Image size 871x871, ONH-centered crop from a color fundus image — 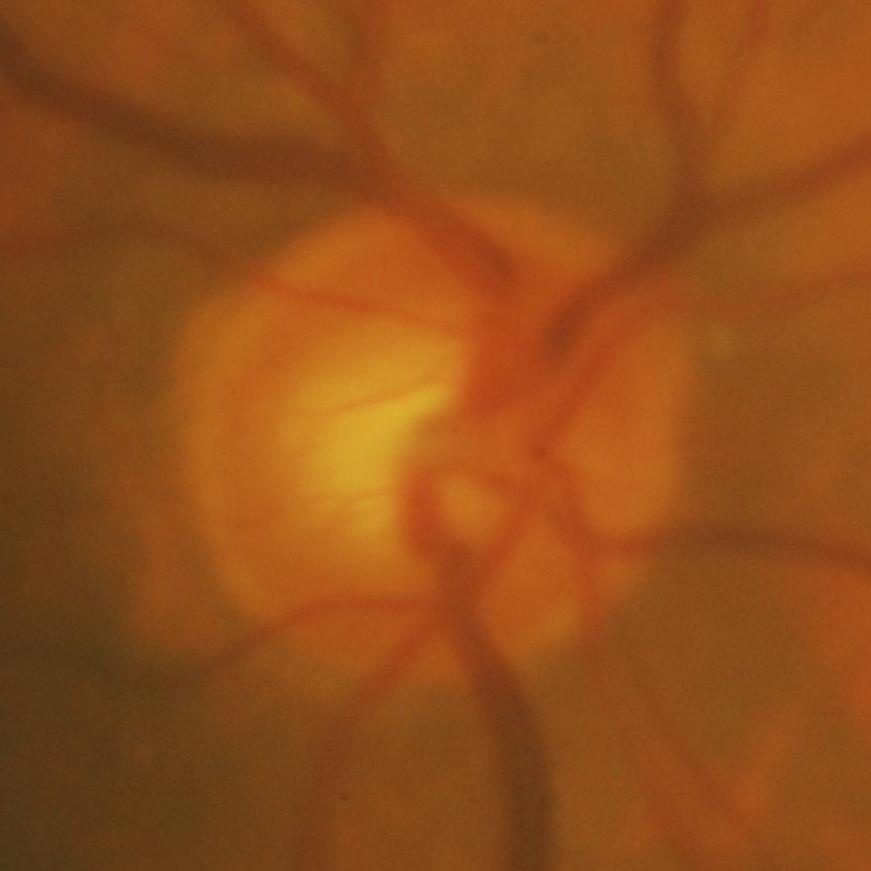

Showing glaucomatous findings.